Modified Davis classification.
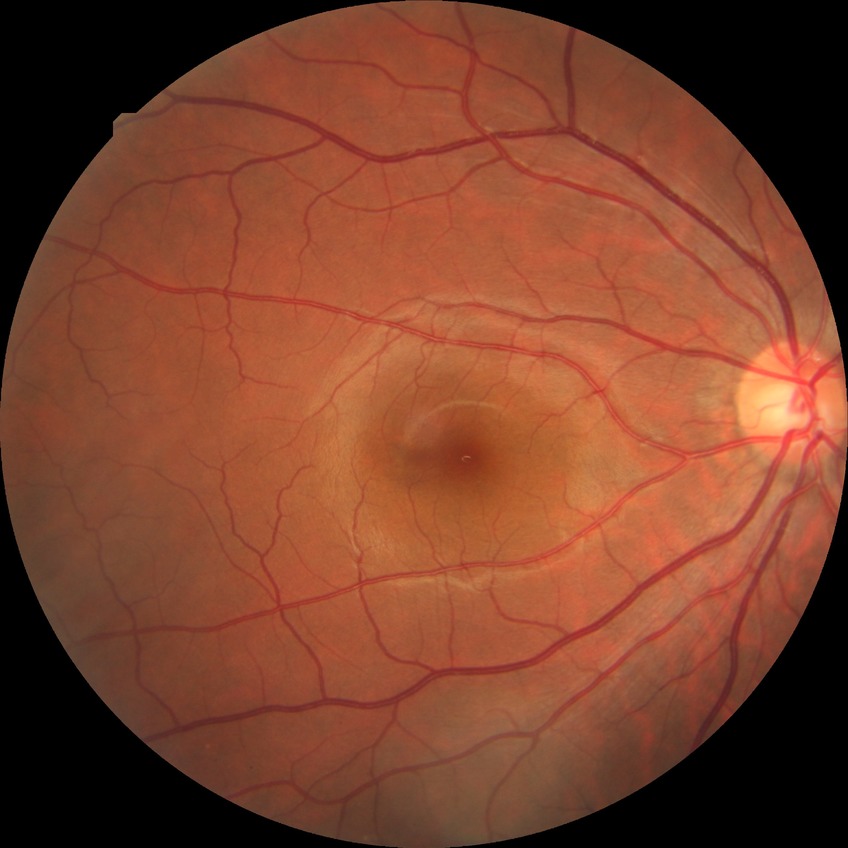 Retinopathy stage: no diabetic retinopathy.